Wide-field fundus photograph of an infant.
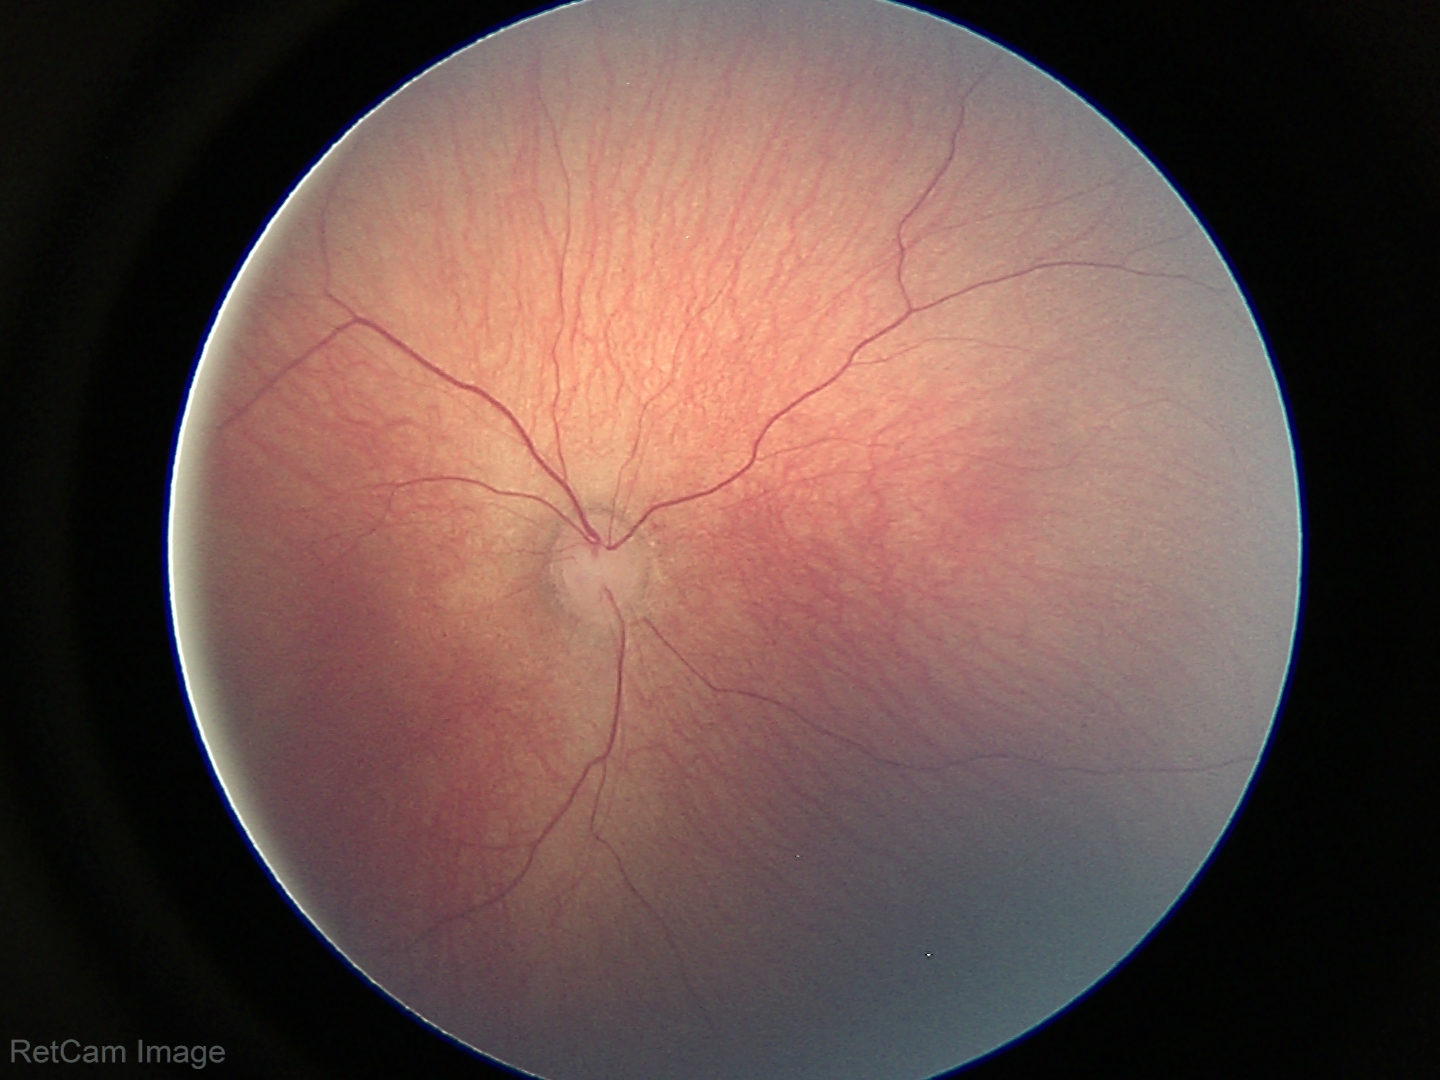

Normal screening examination.